Color fundus photograph — 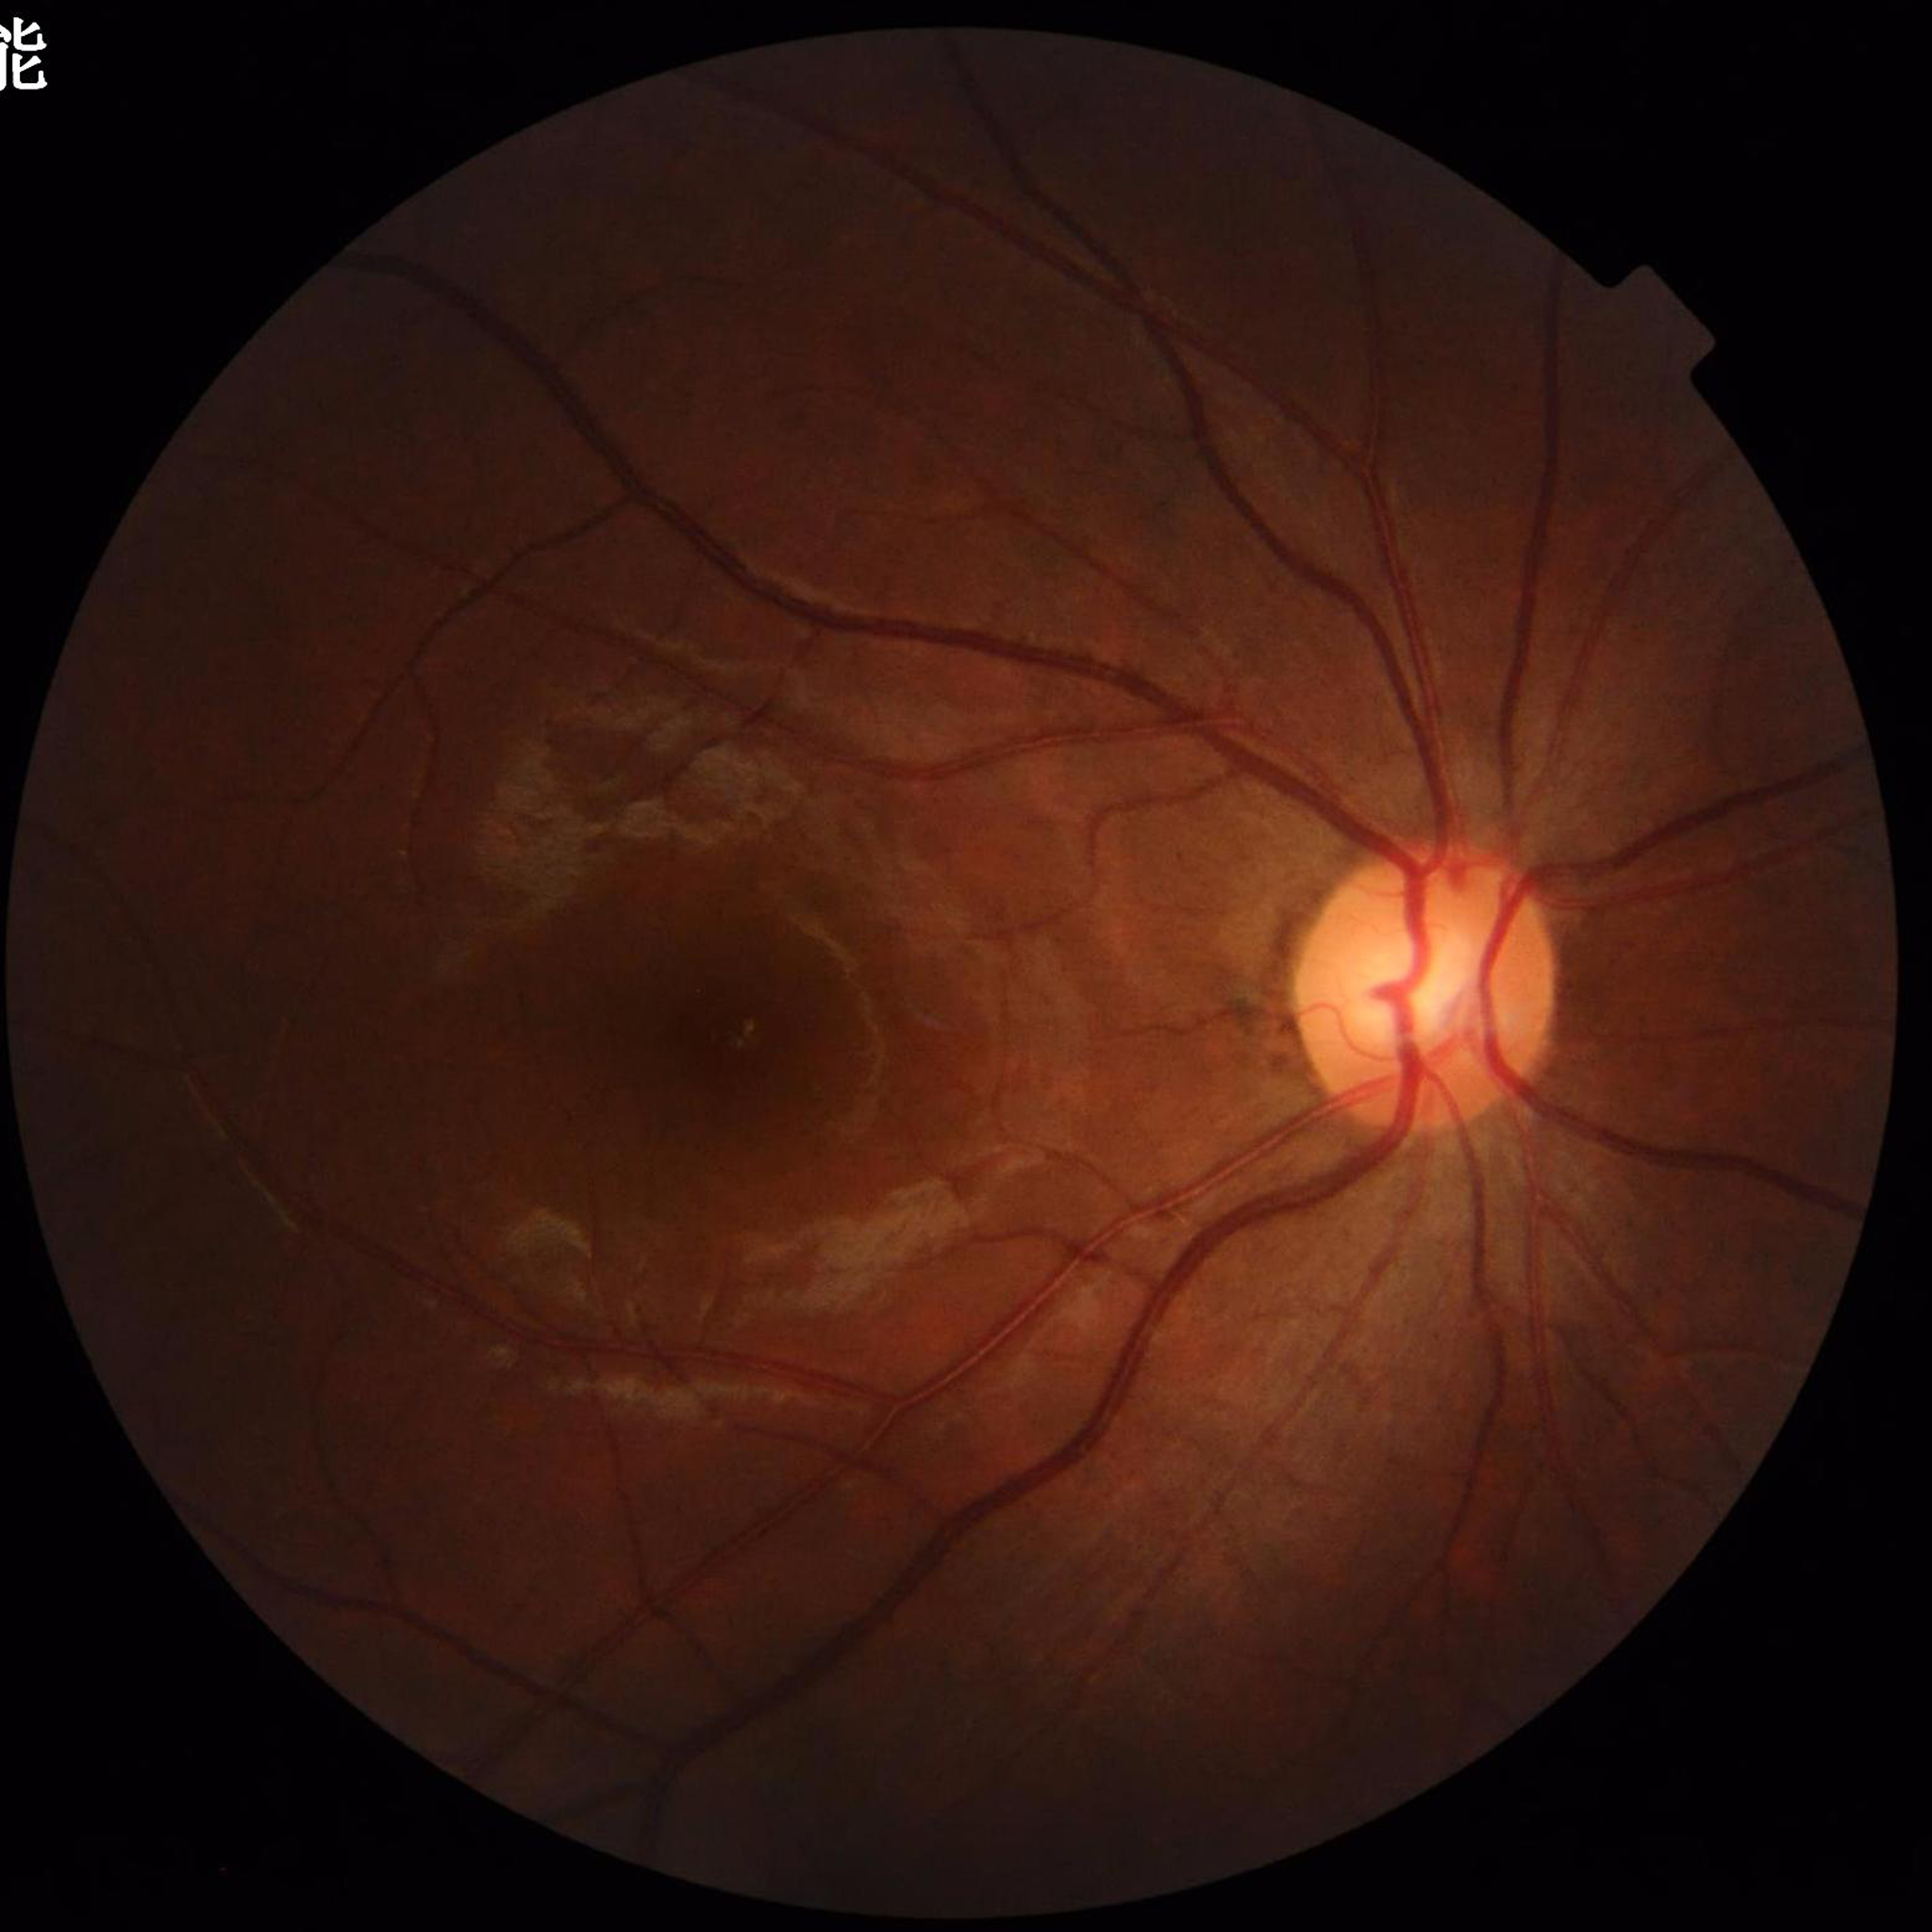
Quality assessment: reduced — illumination/color distortion.
Diagnosed with glaucoma.